Man patient · 2212 by 1661 pixels · retinal fundus photograph · 30° FOV · disc-centered field.
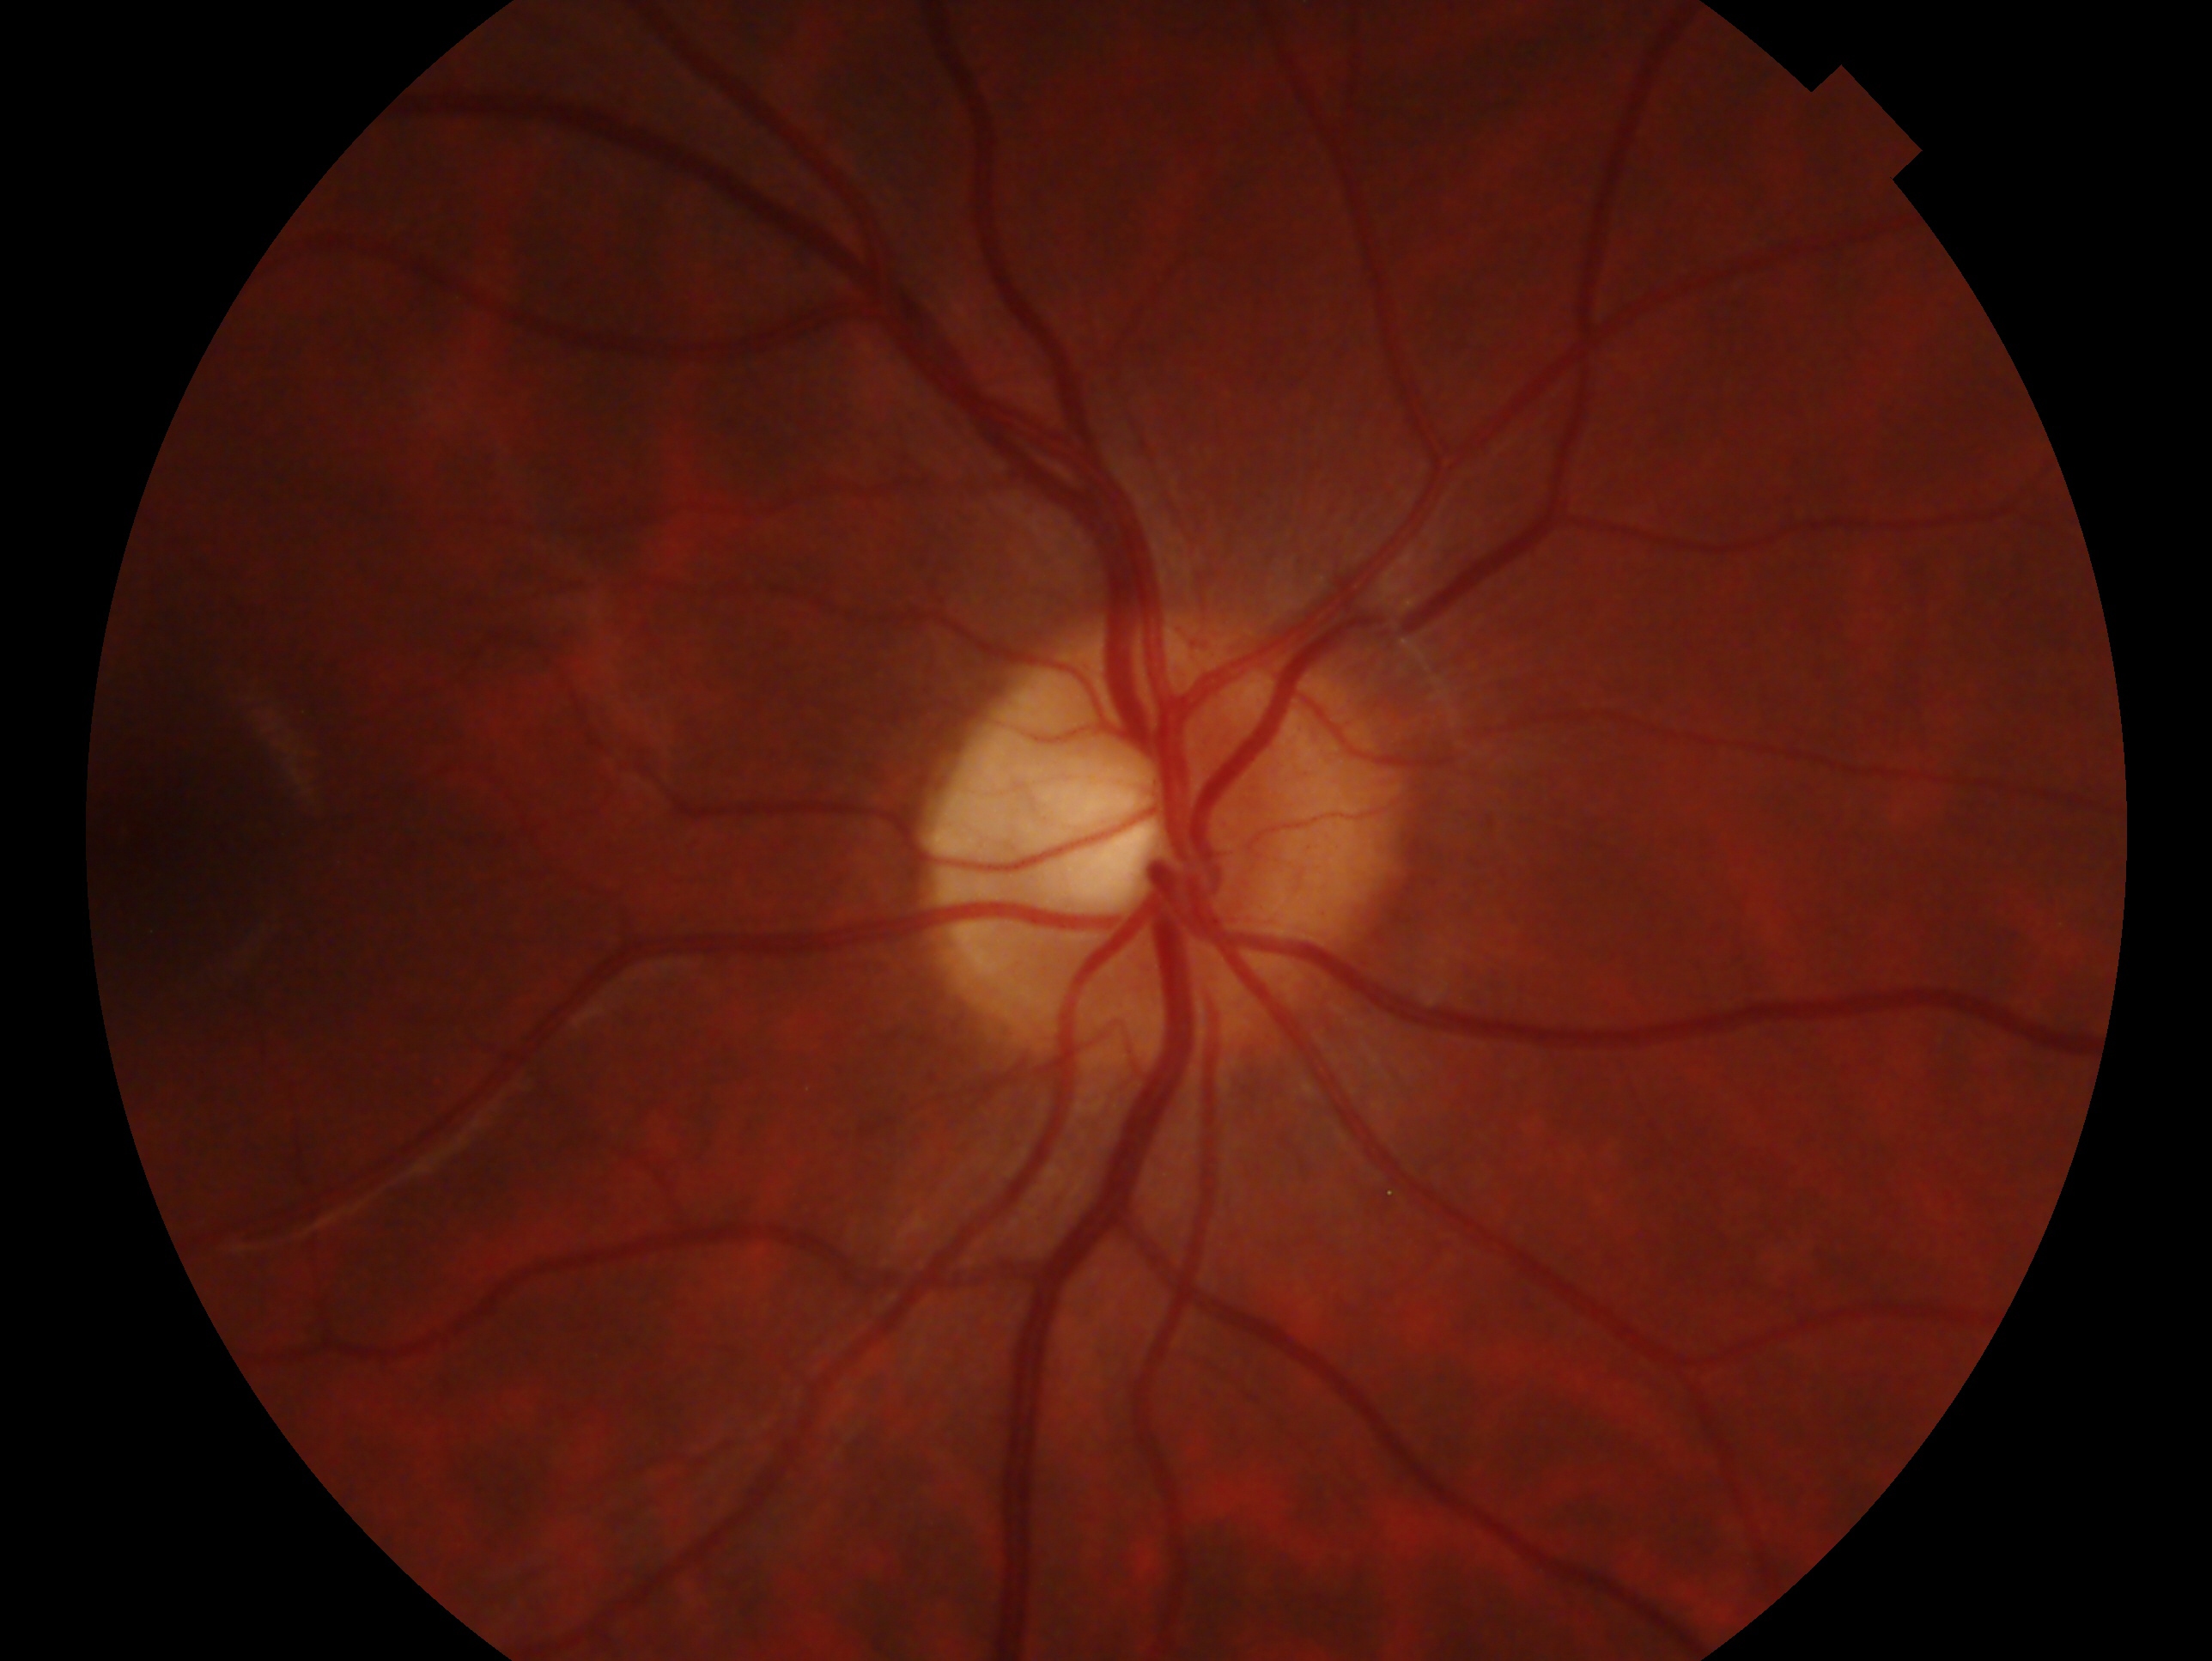 Diagnosis: no glaucomatous findings — no clinical evidence of glaucoma in this eye. Eye: oculus dexter.